200-degree field of view:
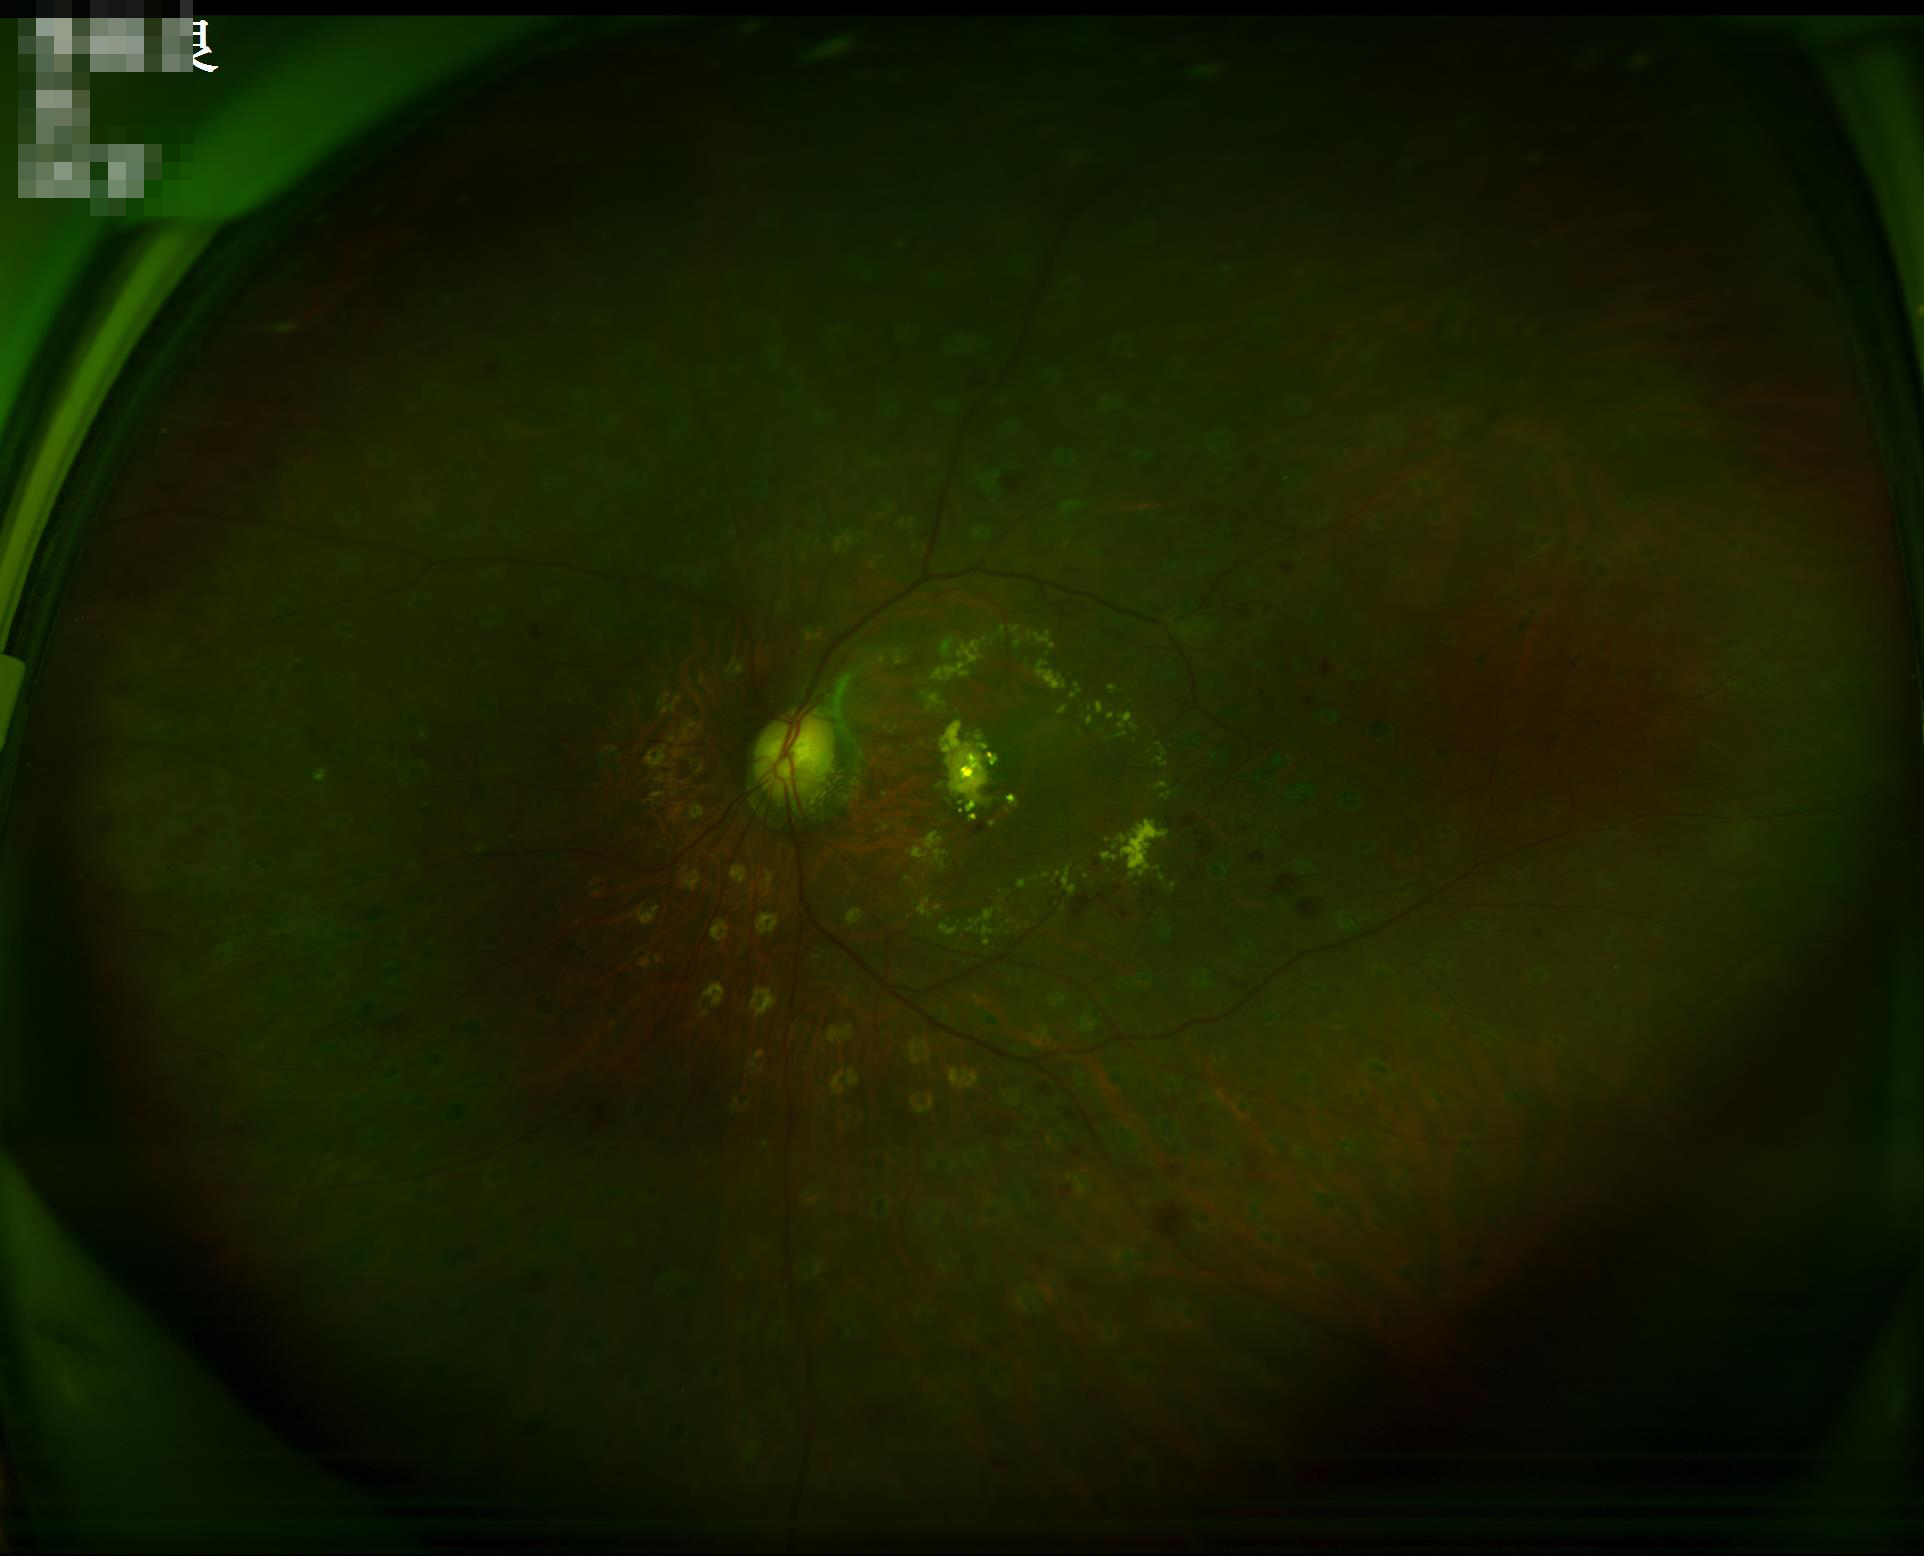

Illumination = poor
Contrast = satisfactory
Overall = poor